2048 by 1536 pixels, fundus photo — 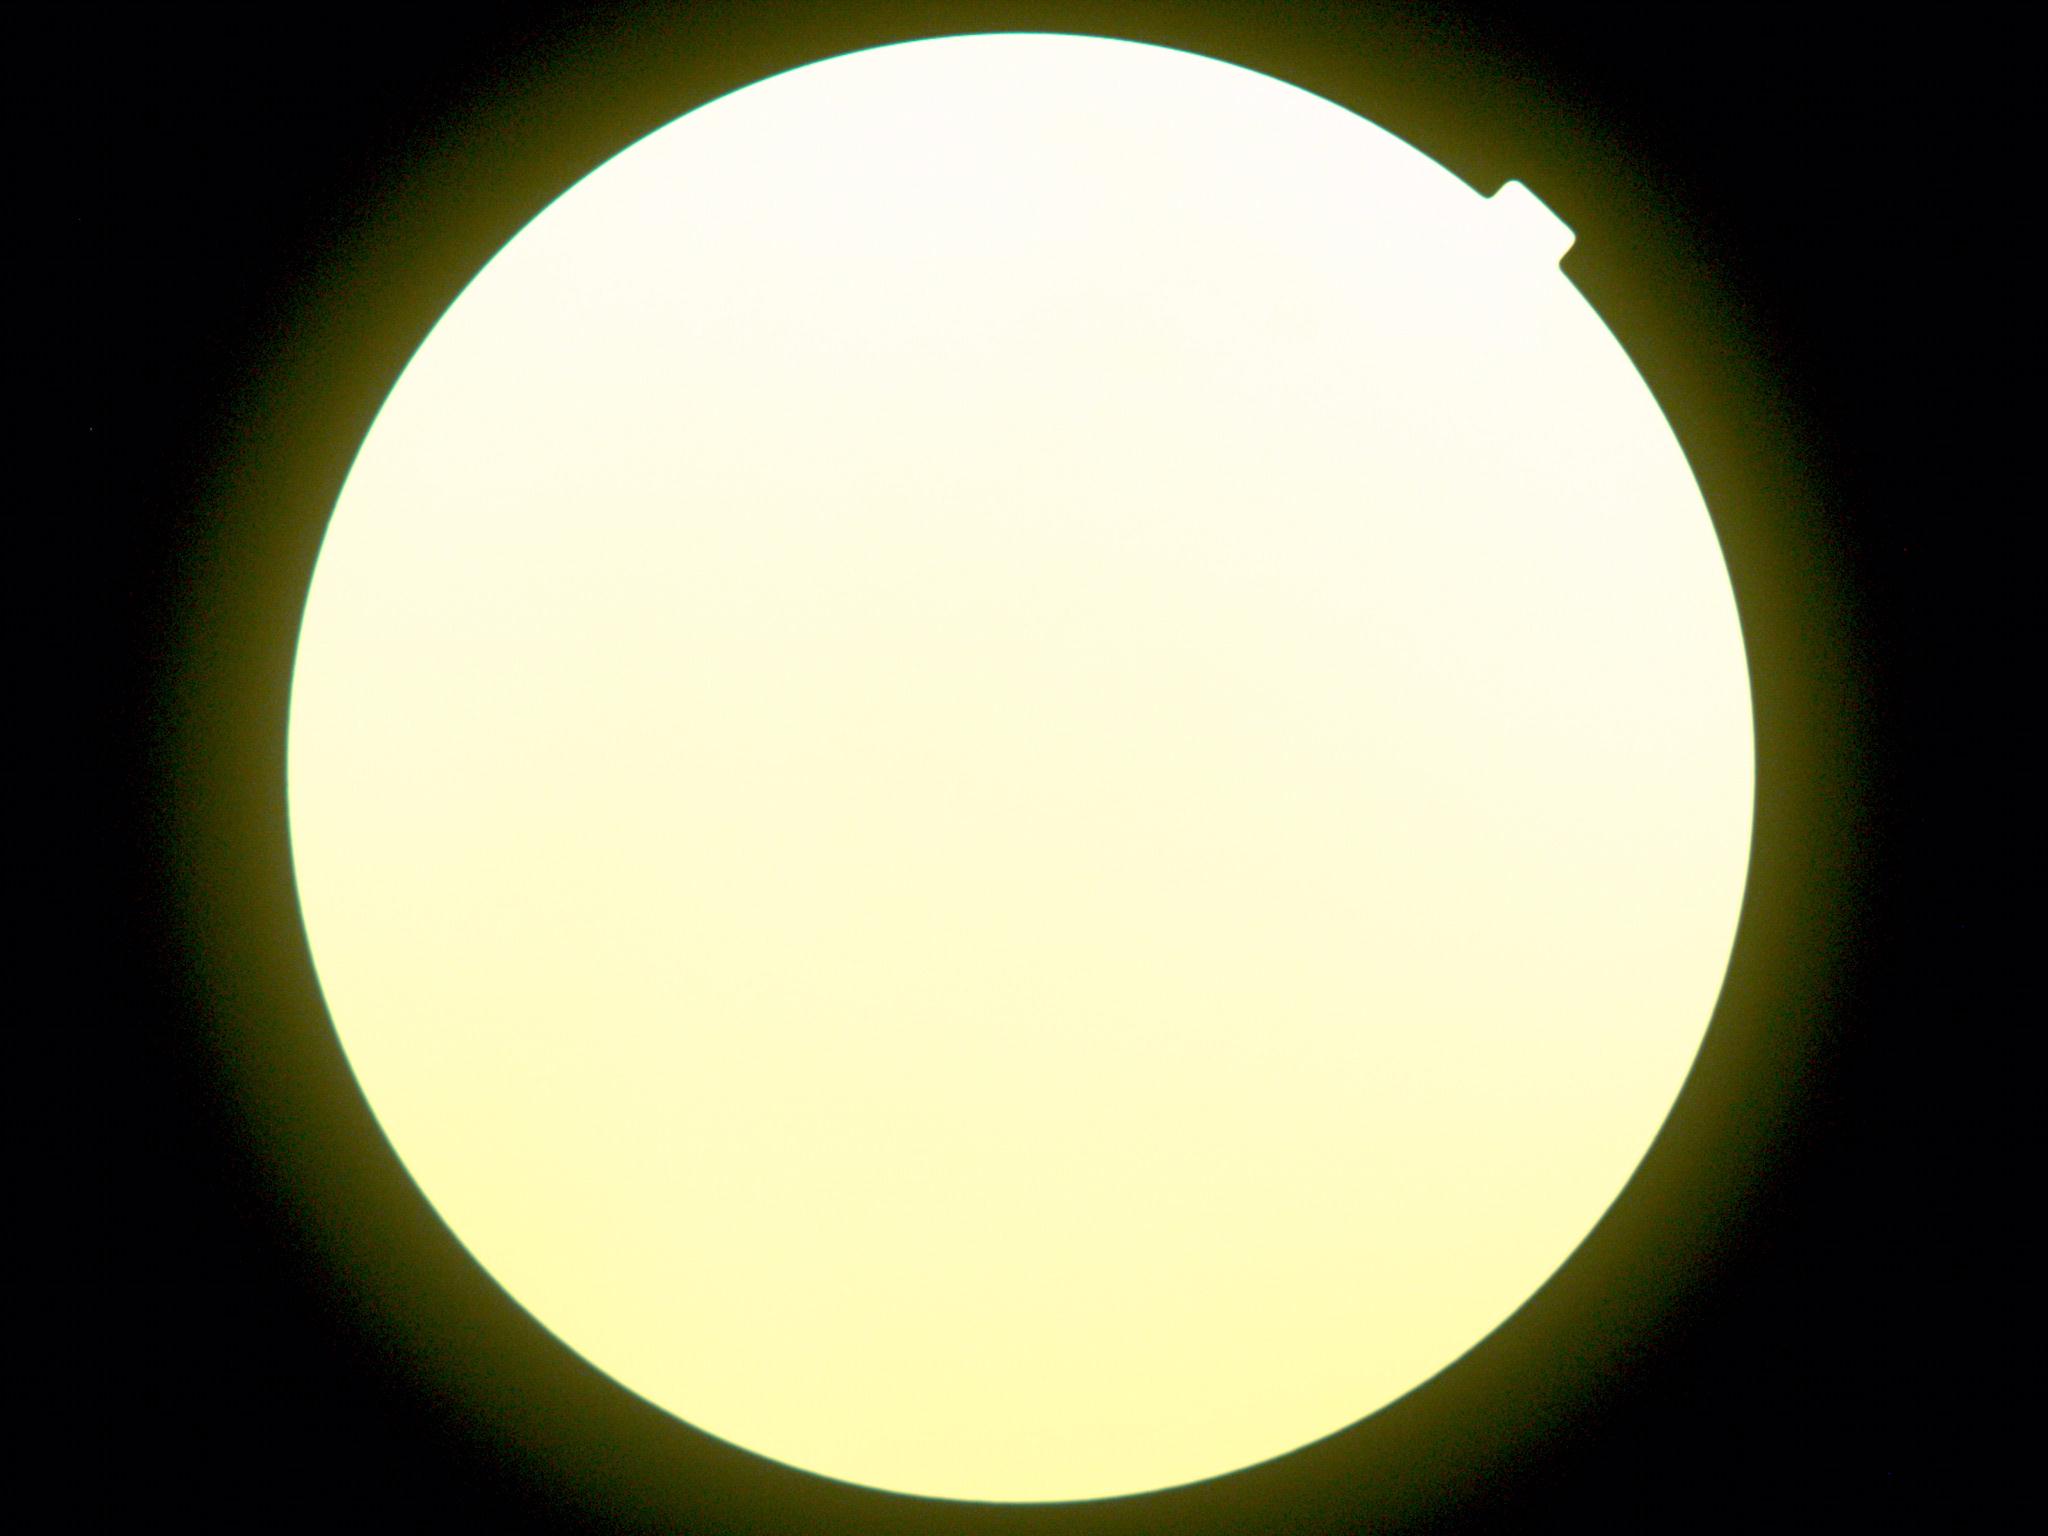 DR is ungradable due to poor image quality. The image cannot be graded for diabetic retinopathy.